Davis DR grading · 45 degree fundus photograph
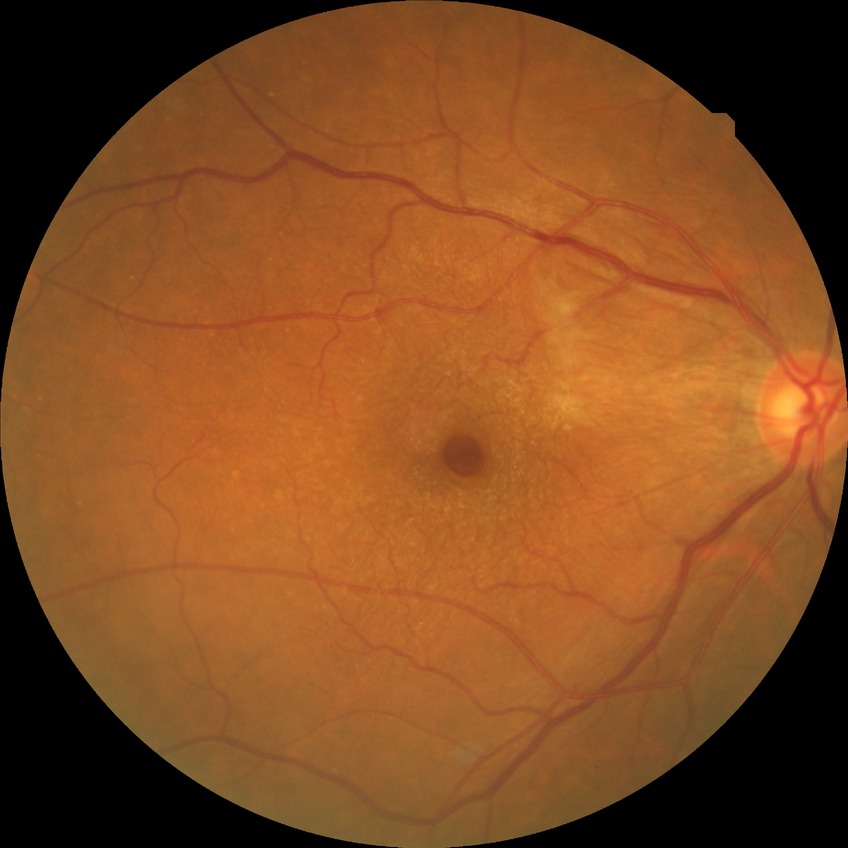 DR impression = no signs of DR | DR severity = NDR.